2346 by 1568 pixels · fundus photo
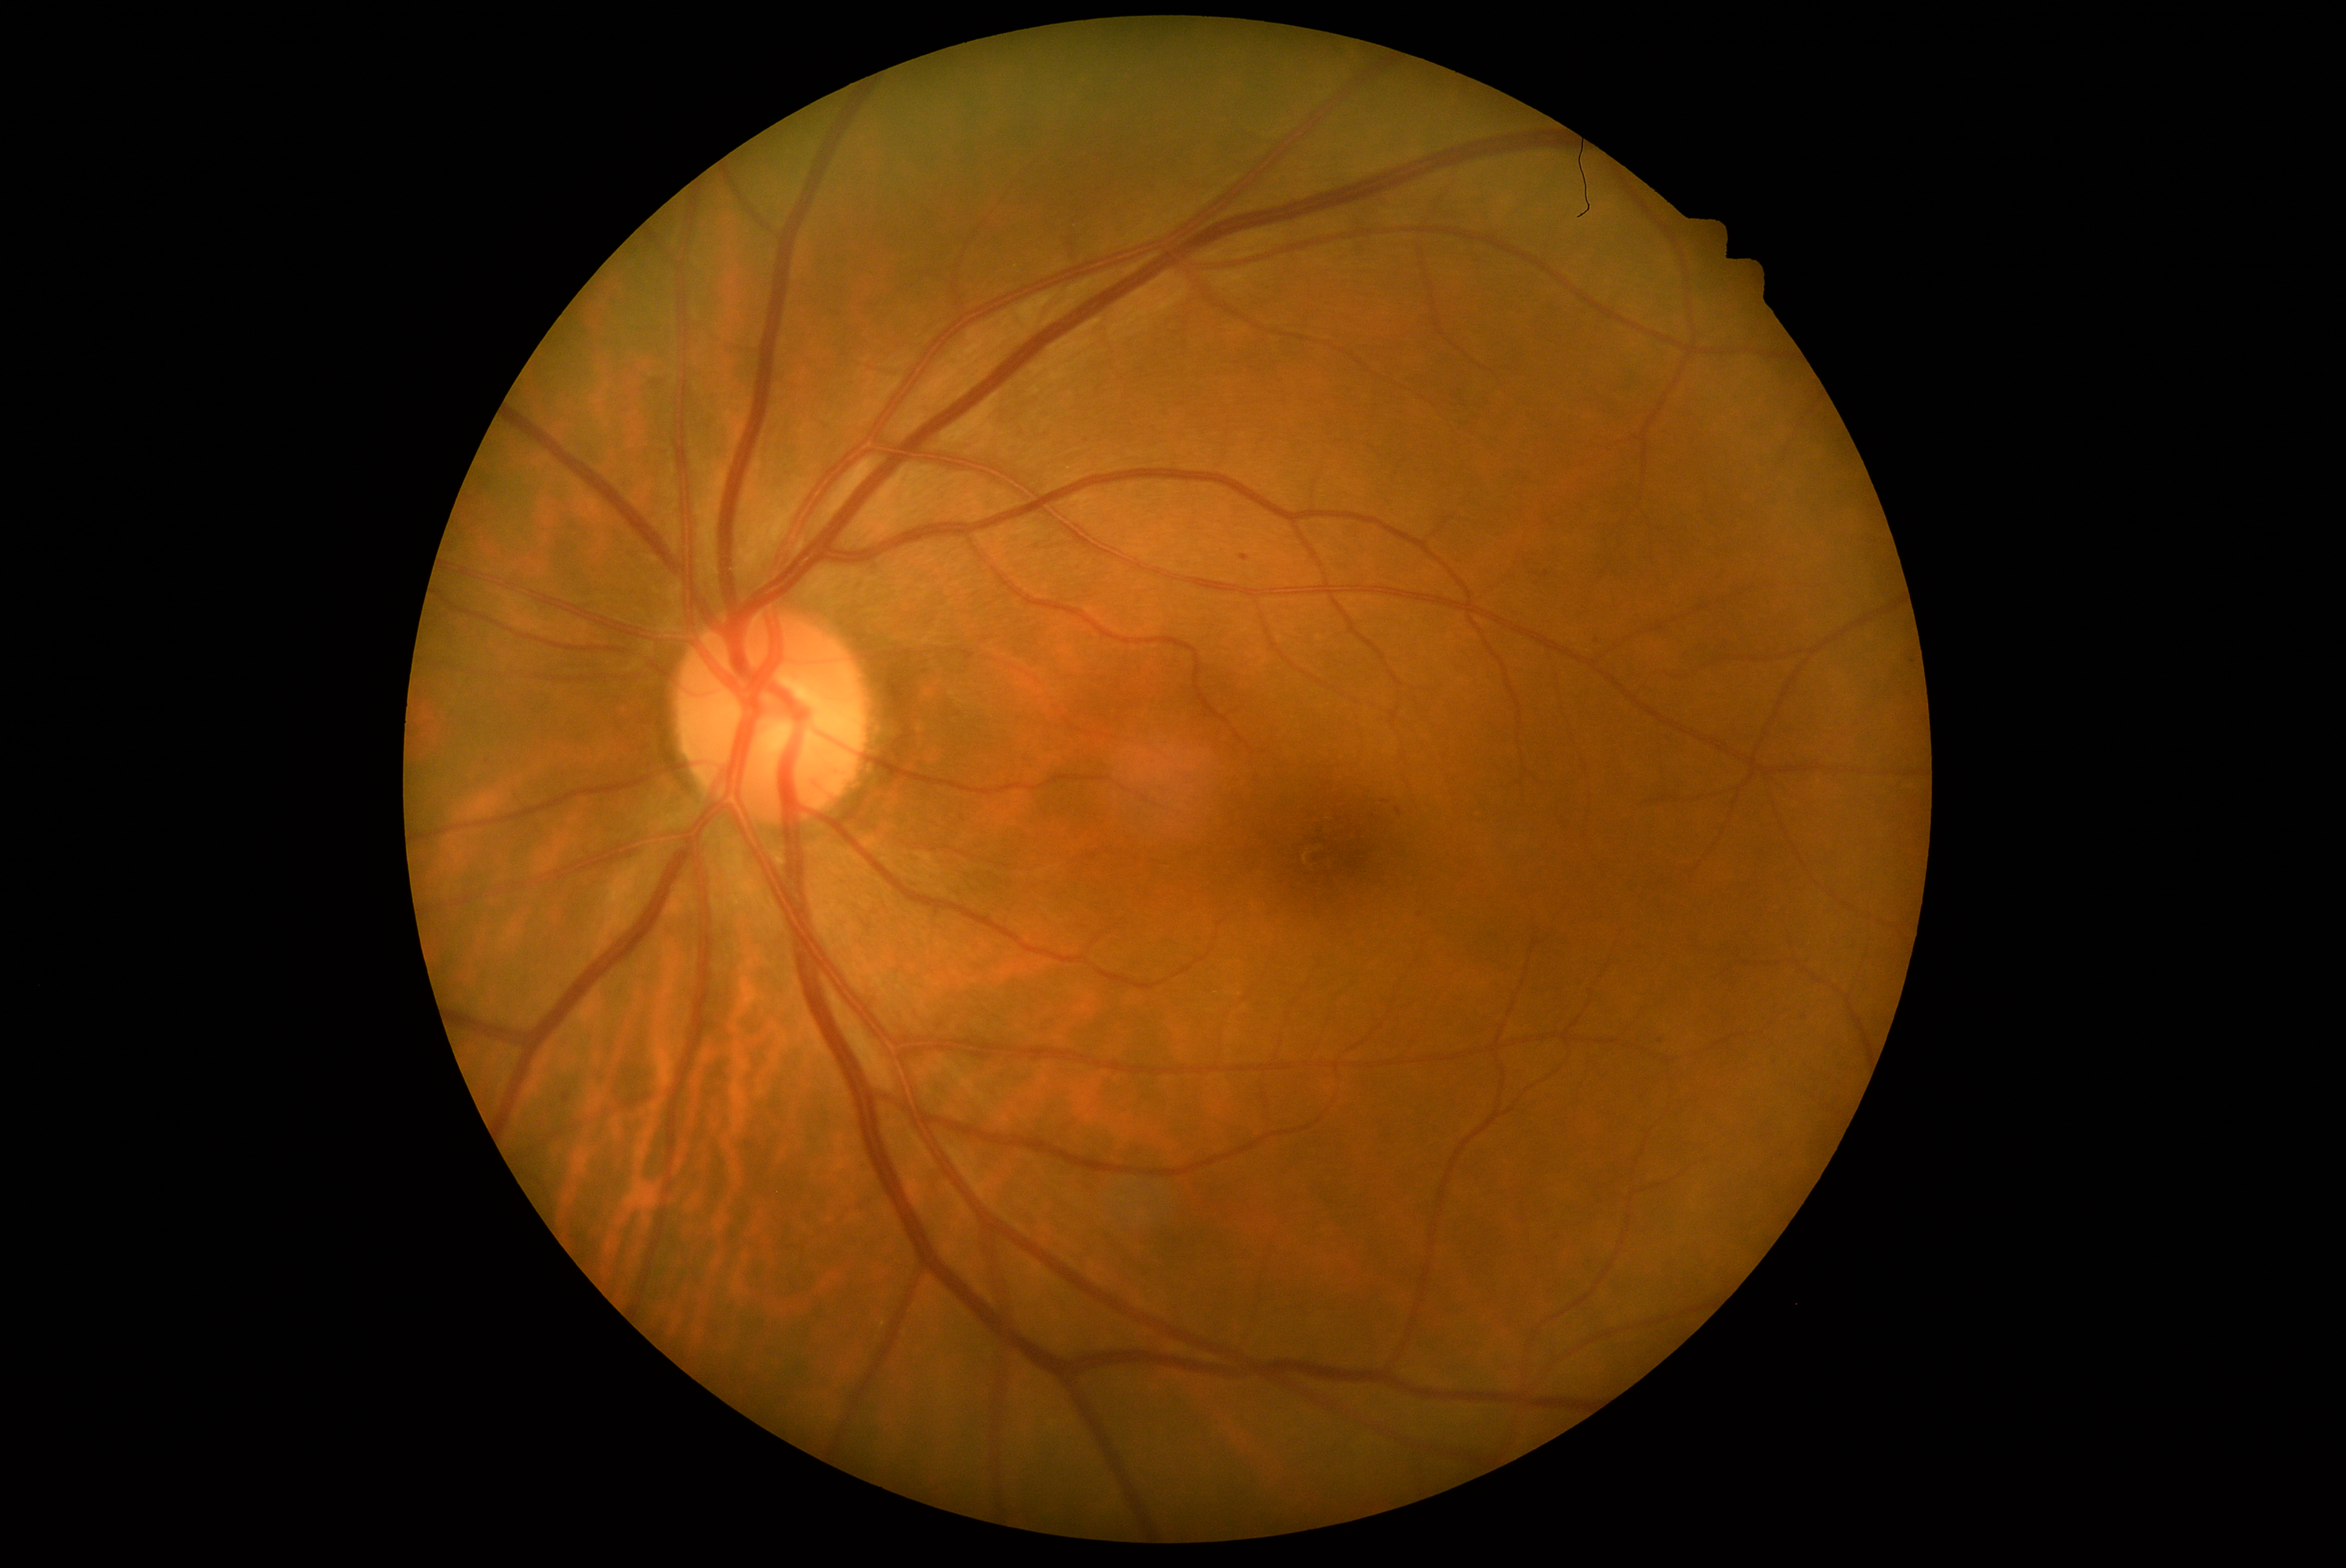 The retinopathy is classified as non-proliferative diabetic retinopathy.
Diabetic retinopathy: 1.